Ultra-widefield fundus photograph: 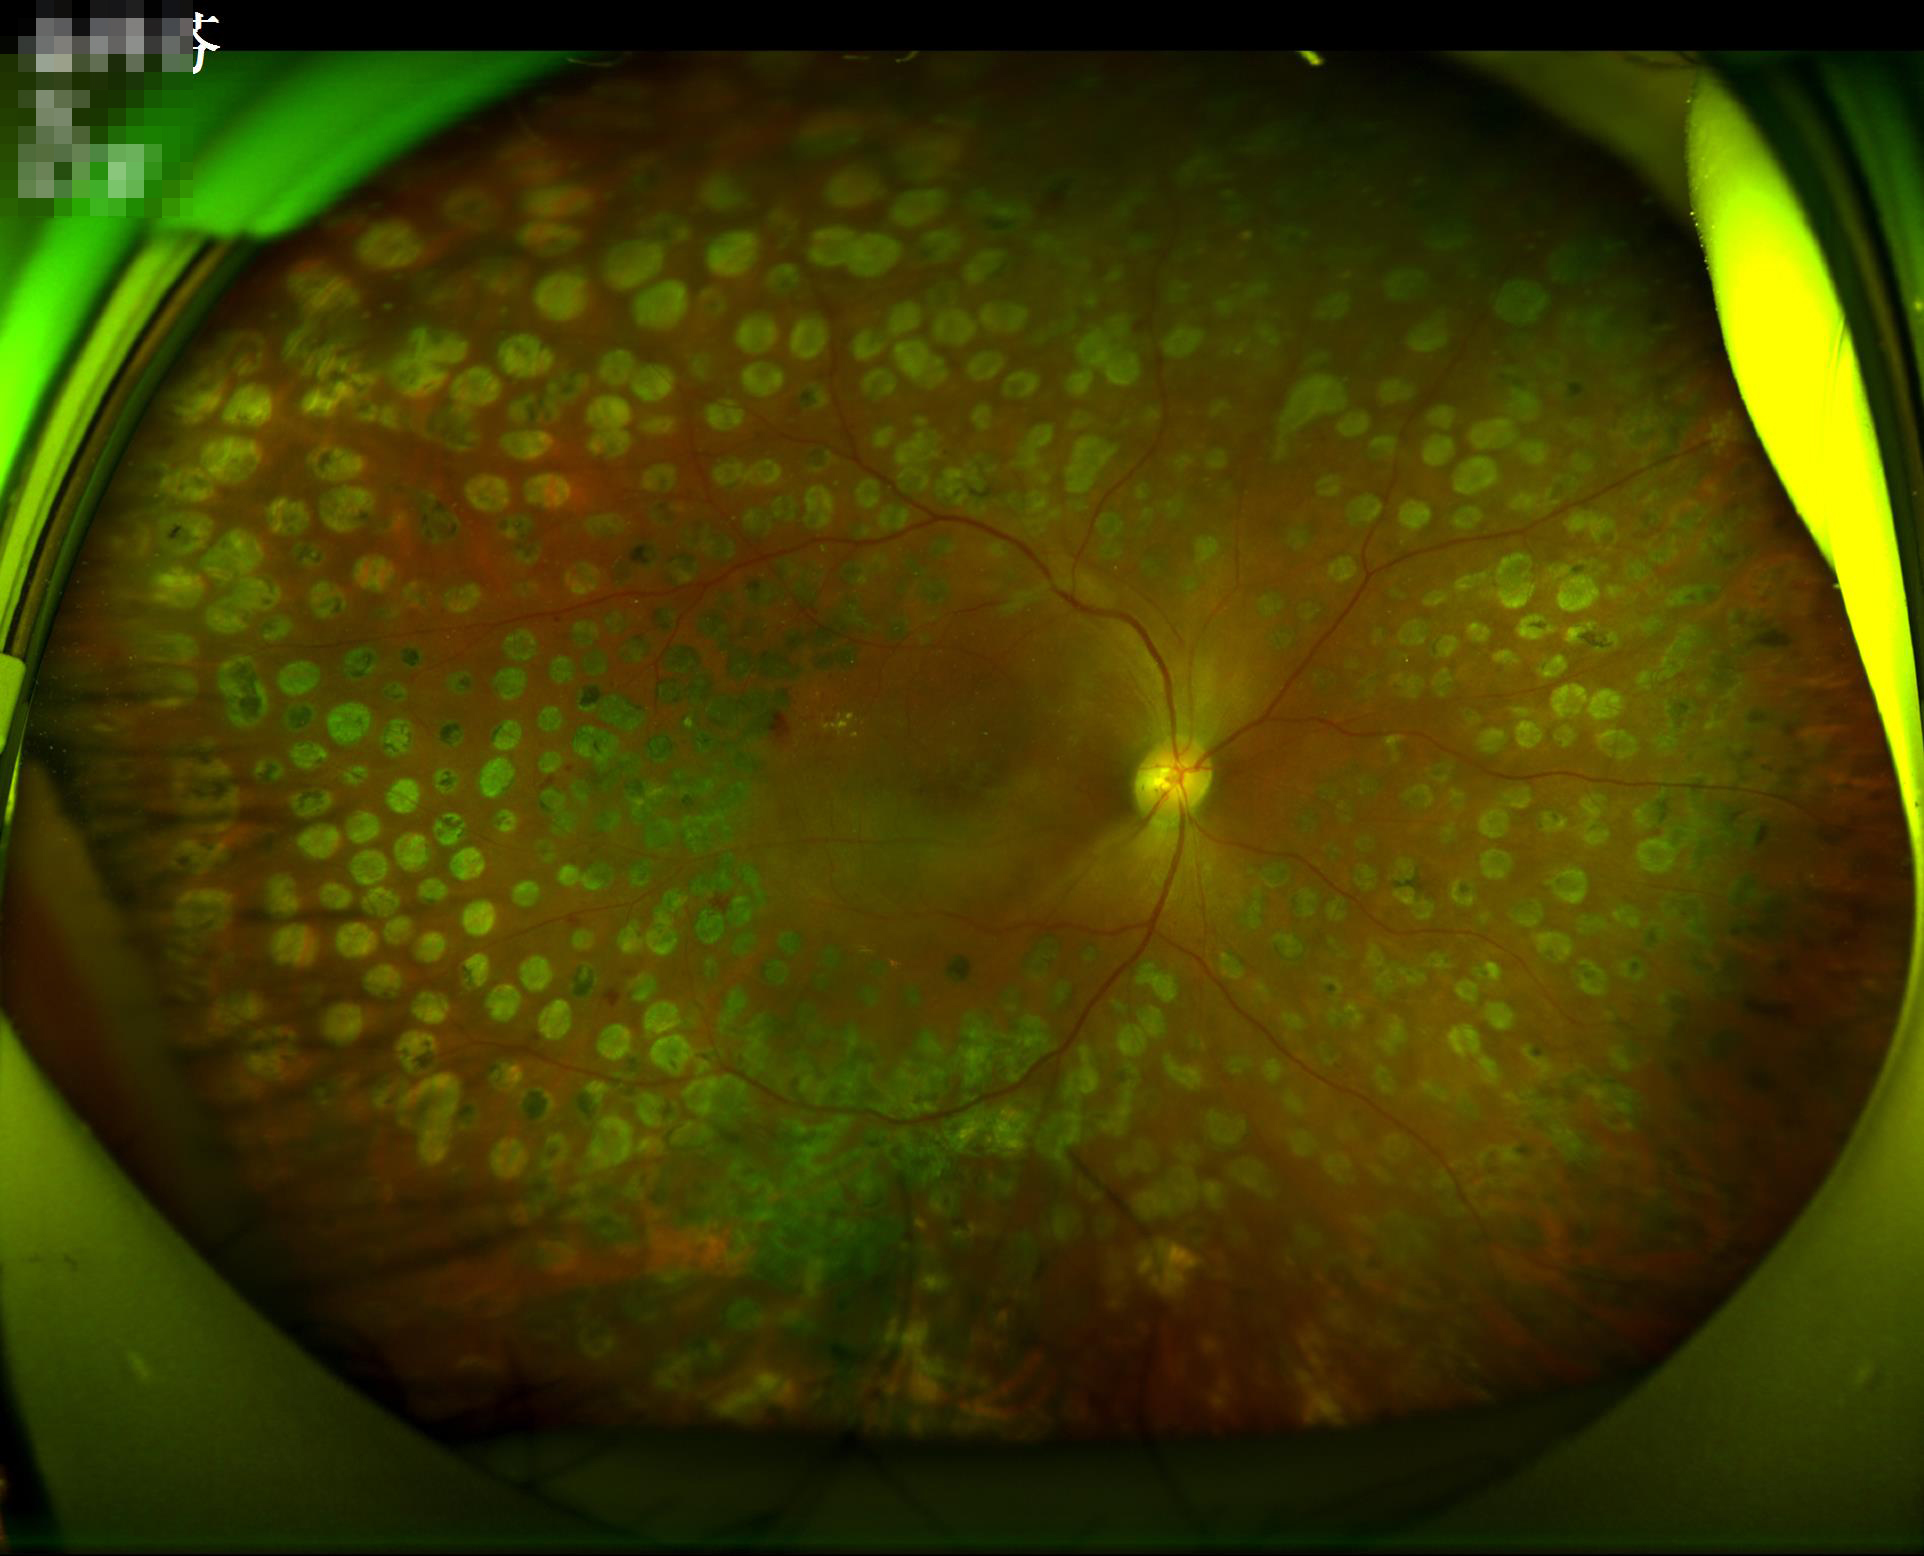

Contrast is good.
Acceptable image quality.